CFP, 512x512
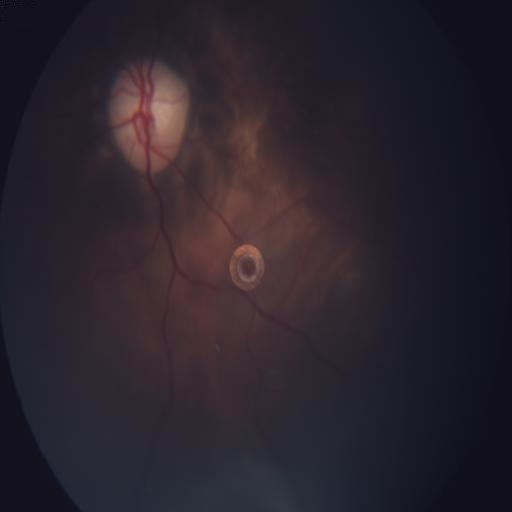 Diagnosis: hemorrhagic pigment epithelial detachment; macular scar.